Nonmydriatic fundus photograph.
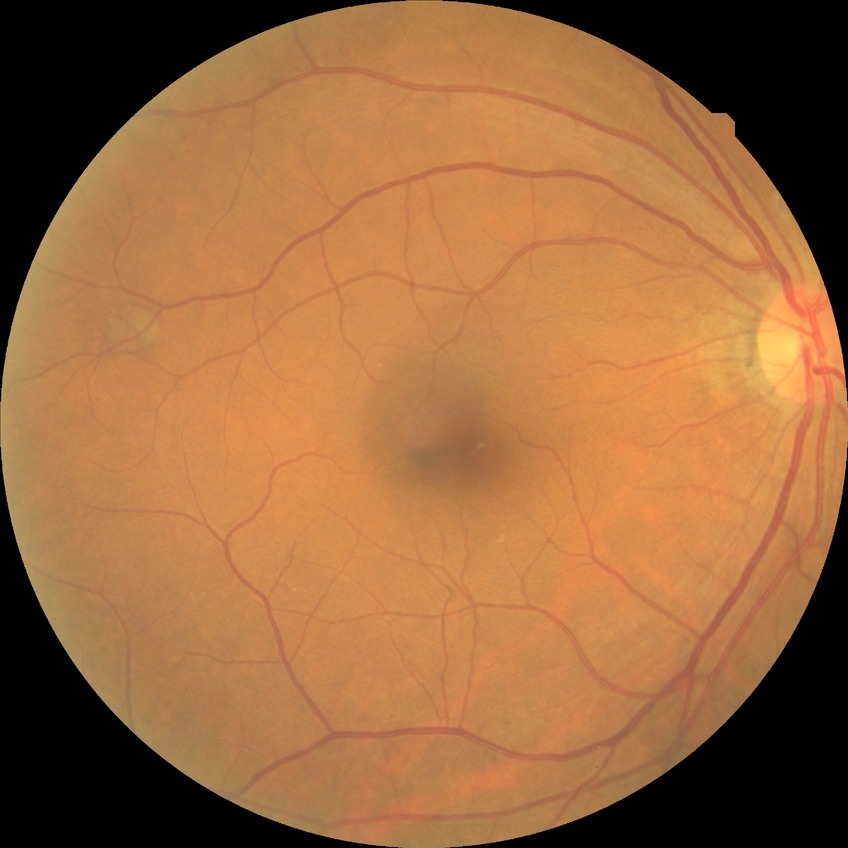
modified Davis classification = no diabetic retinopathy.